Image size 848x848, 45 degree fundus photograph
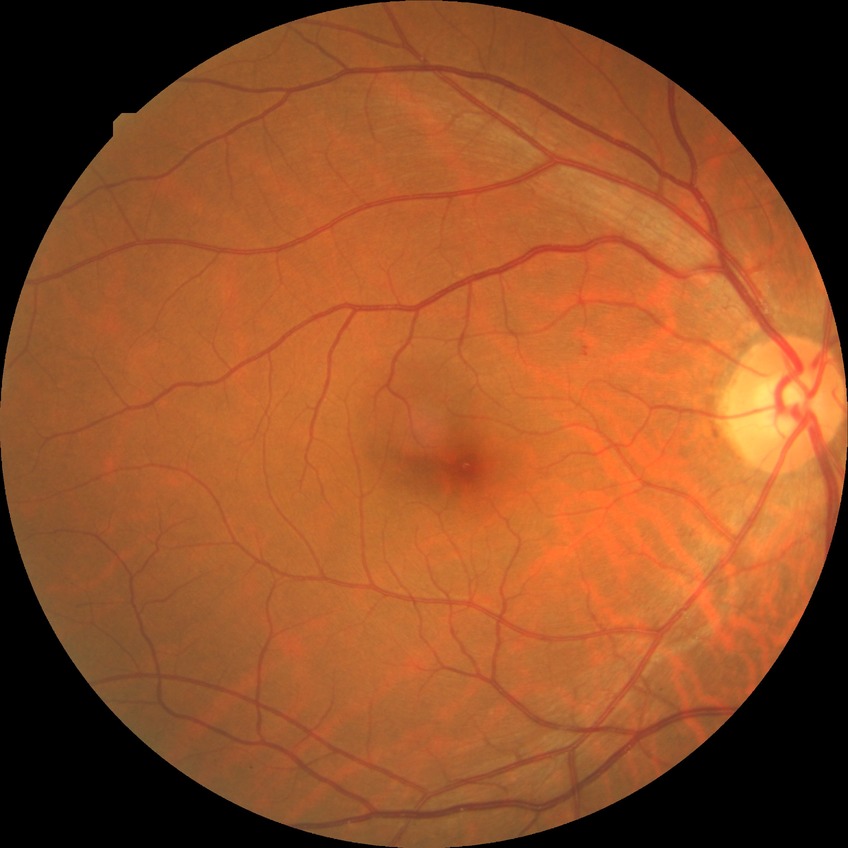

diabetic retinopathy severity: simple diabetic retinopathy.